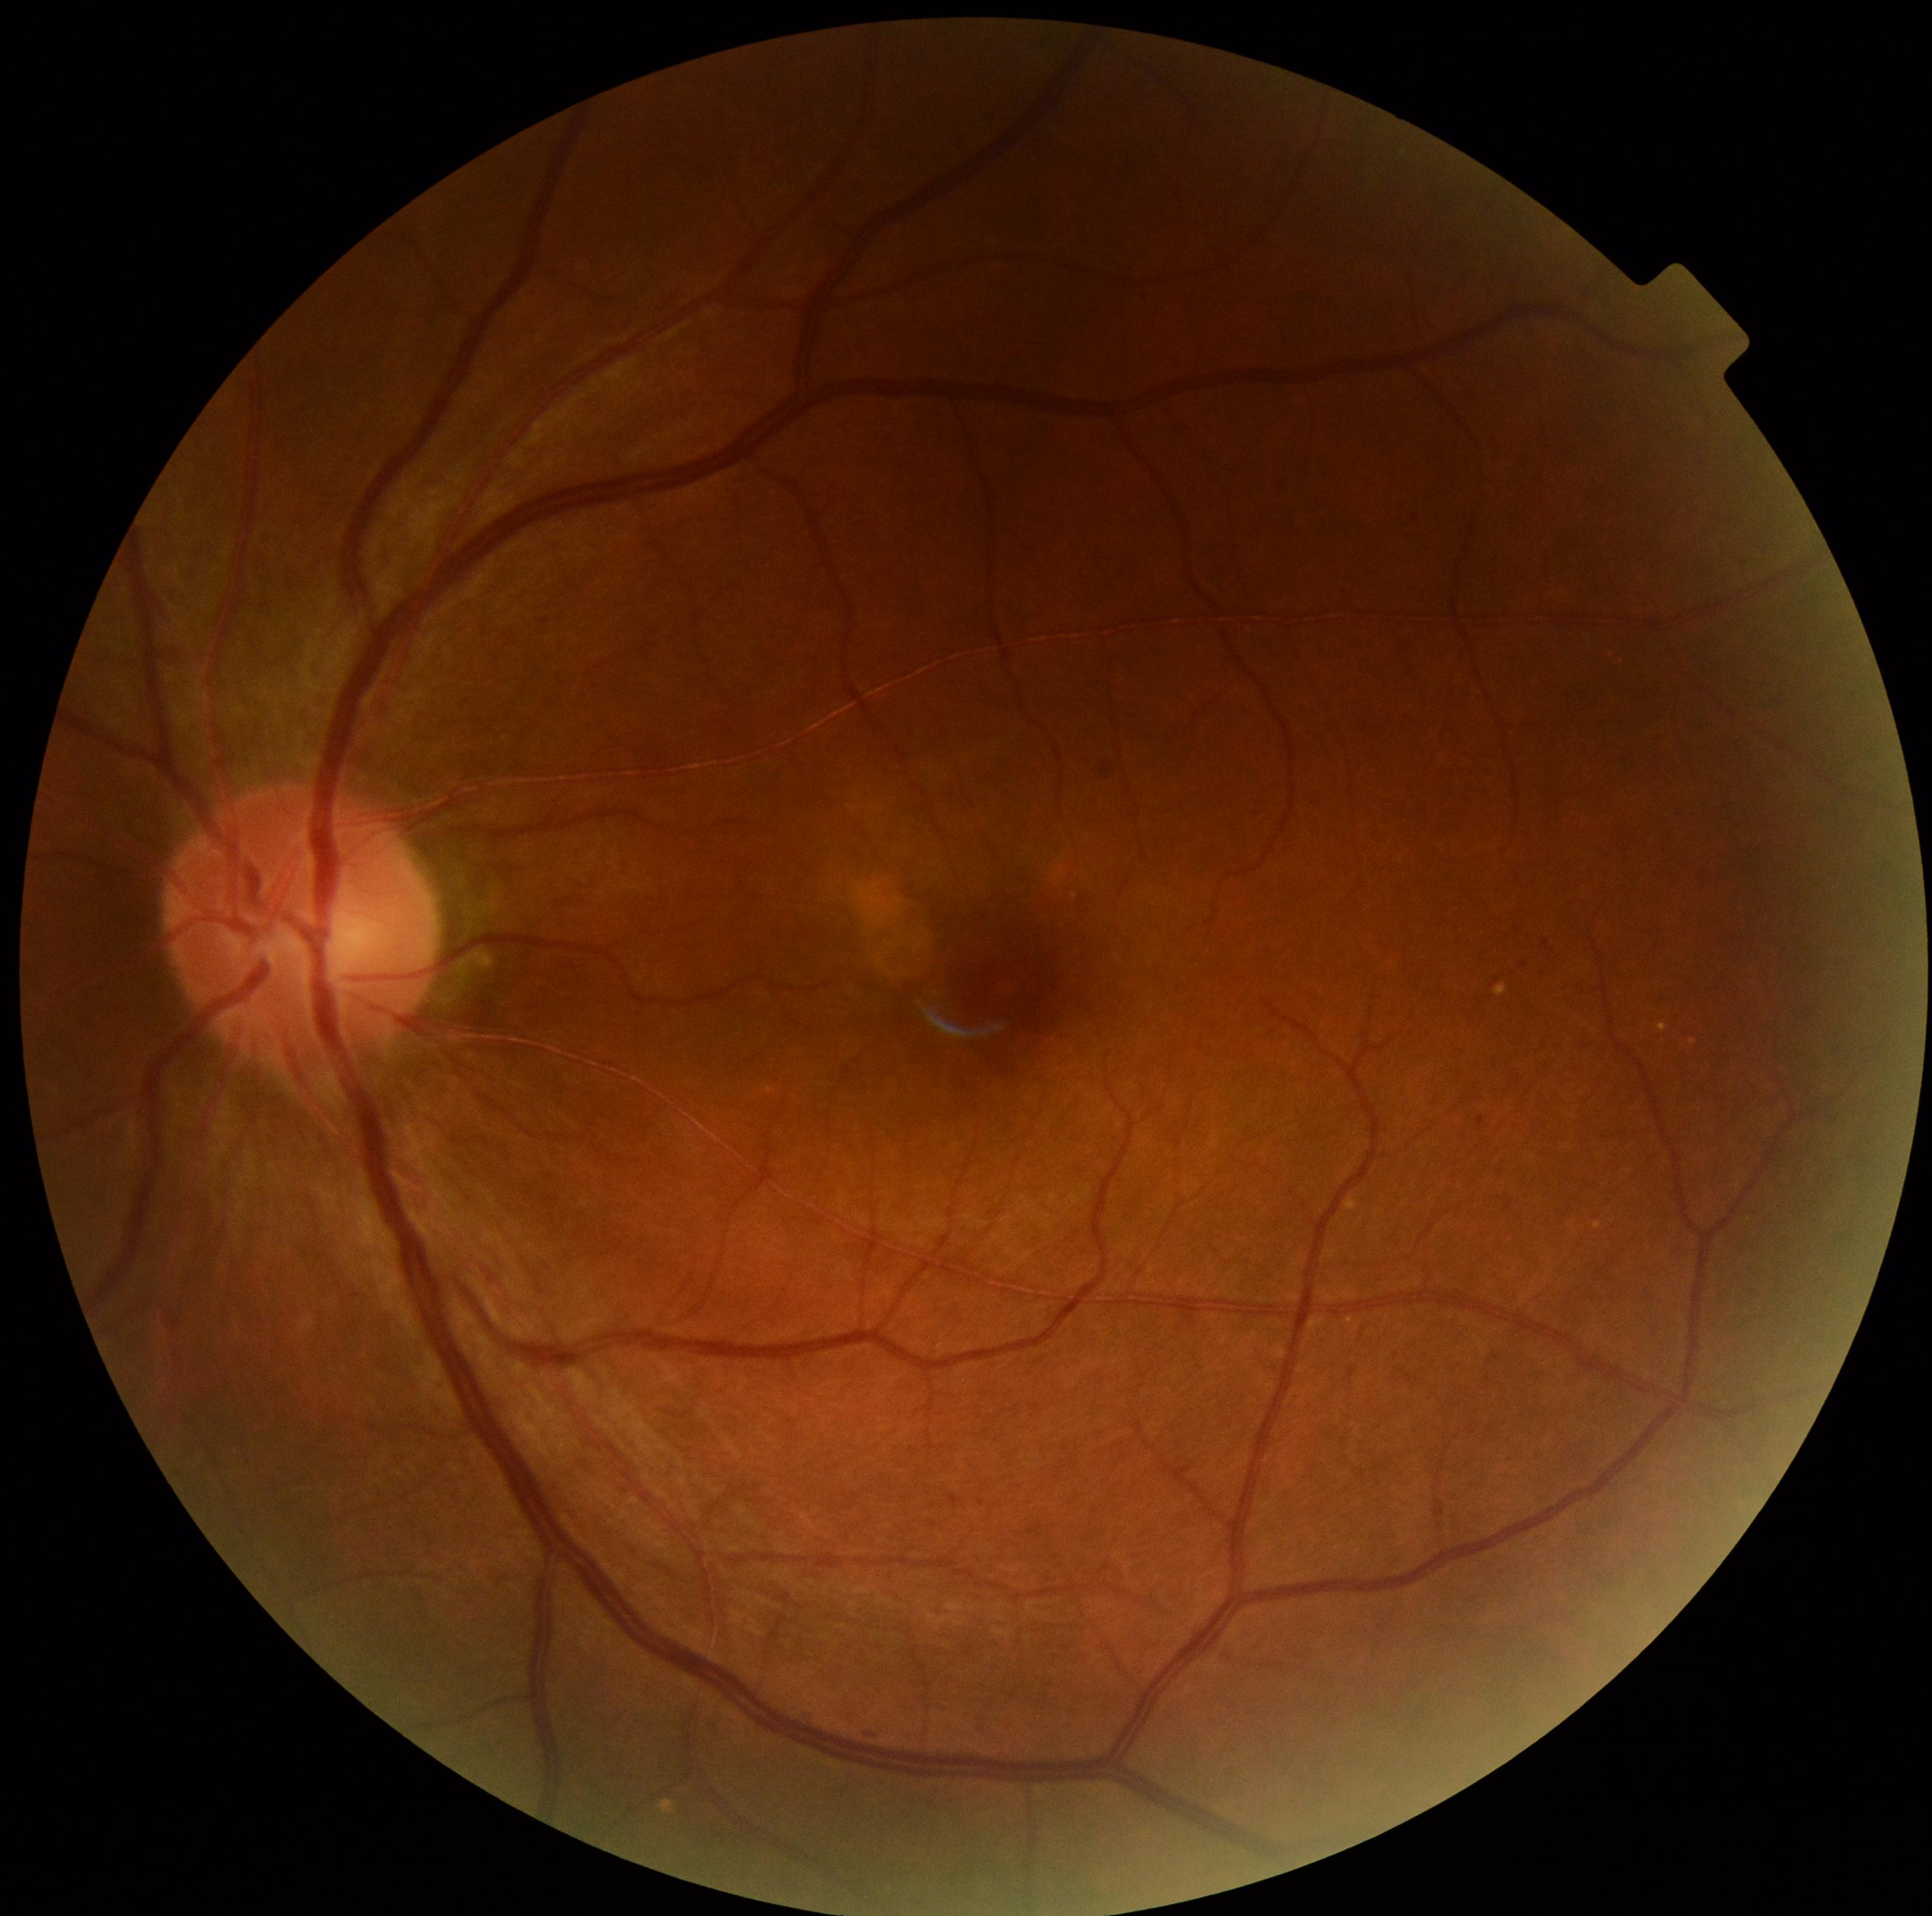
diabetic retinopathy (DR) = grade 2 (moderate NPDR).